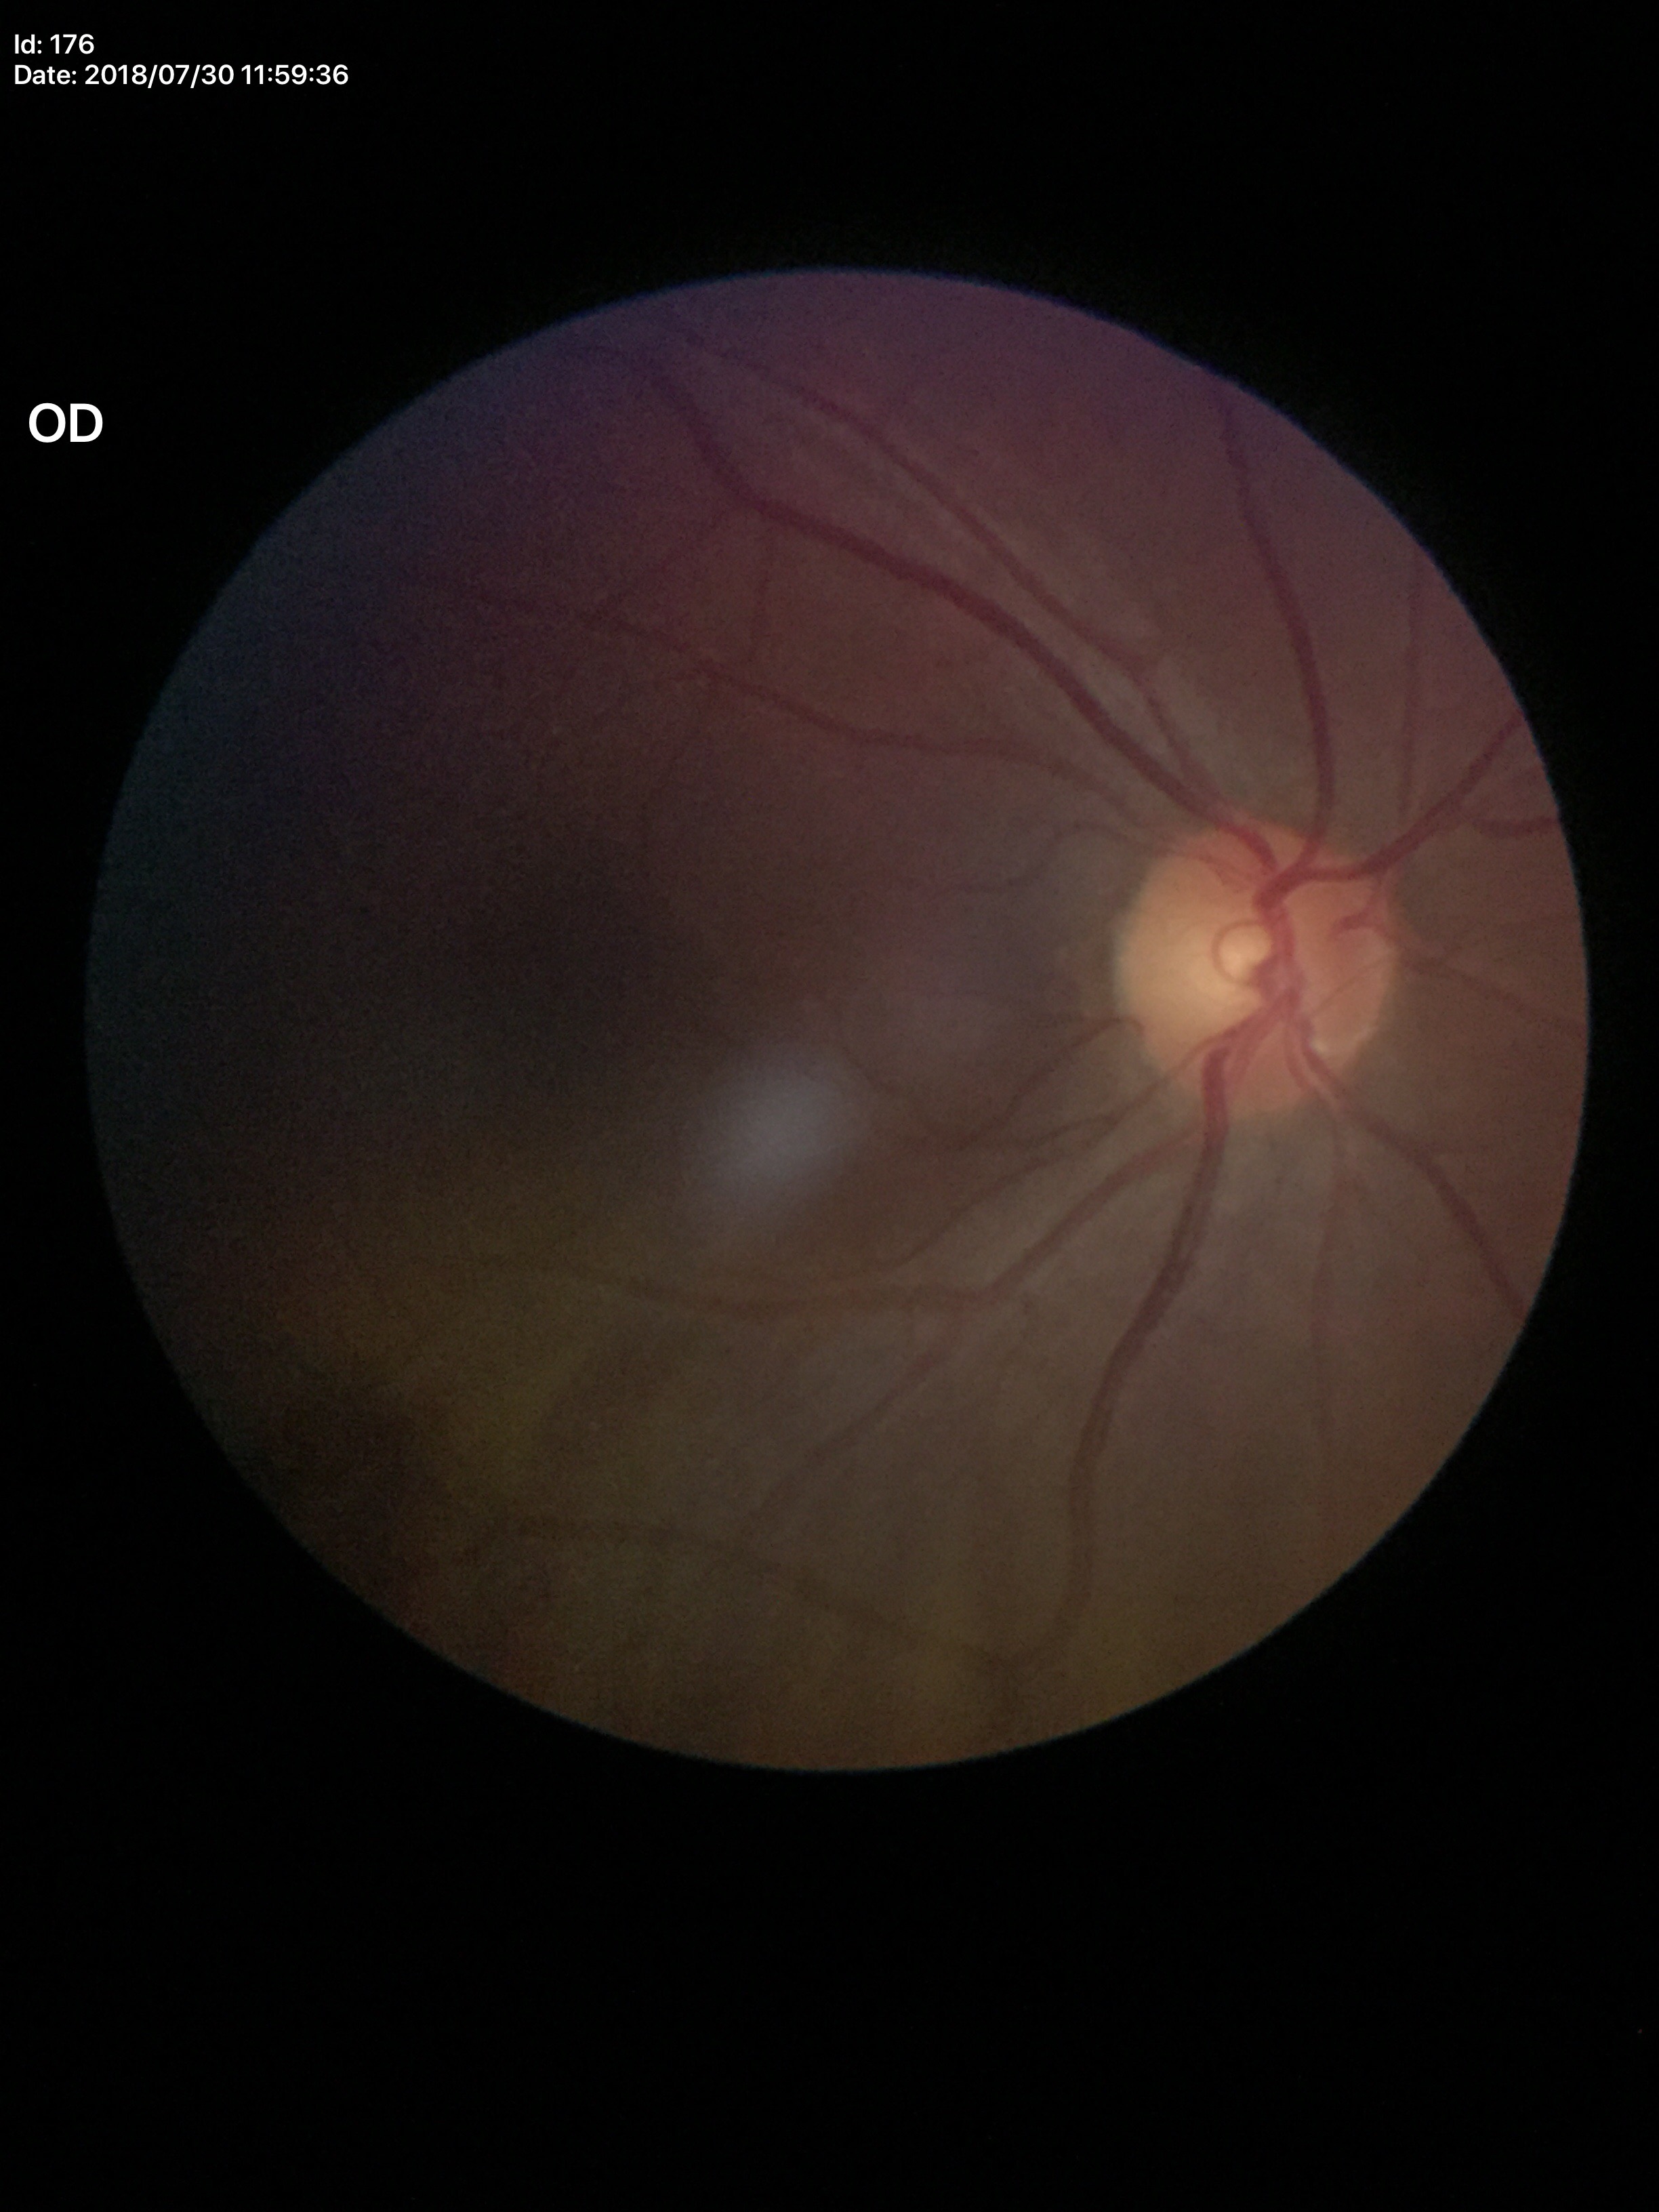 No glaucomatous optic neuropathy (5/5 ophthalmologists in agreement).
Vertical cup-to-disc ratio is 0.48.